130° field of view (Clarity RetCam 3) · wide-field contact fundus photograph of an infant
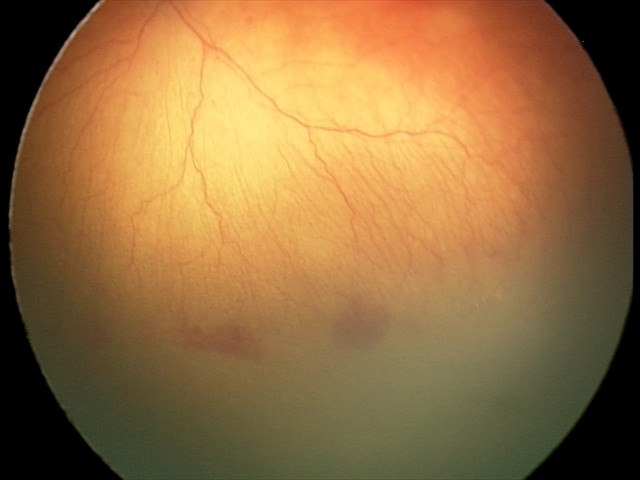

Series diagnosed as A-ROP (aggressive ROP).
Plus disease present.